512x512px: 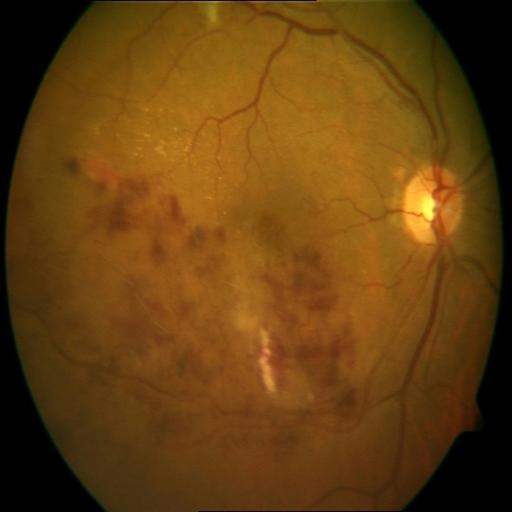

Findings consistent with branch retinal vein occlusion (BRVO).